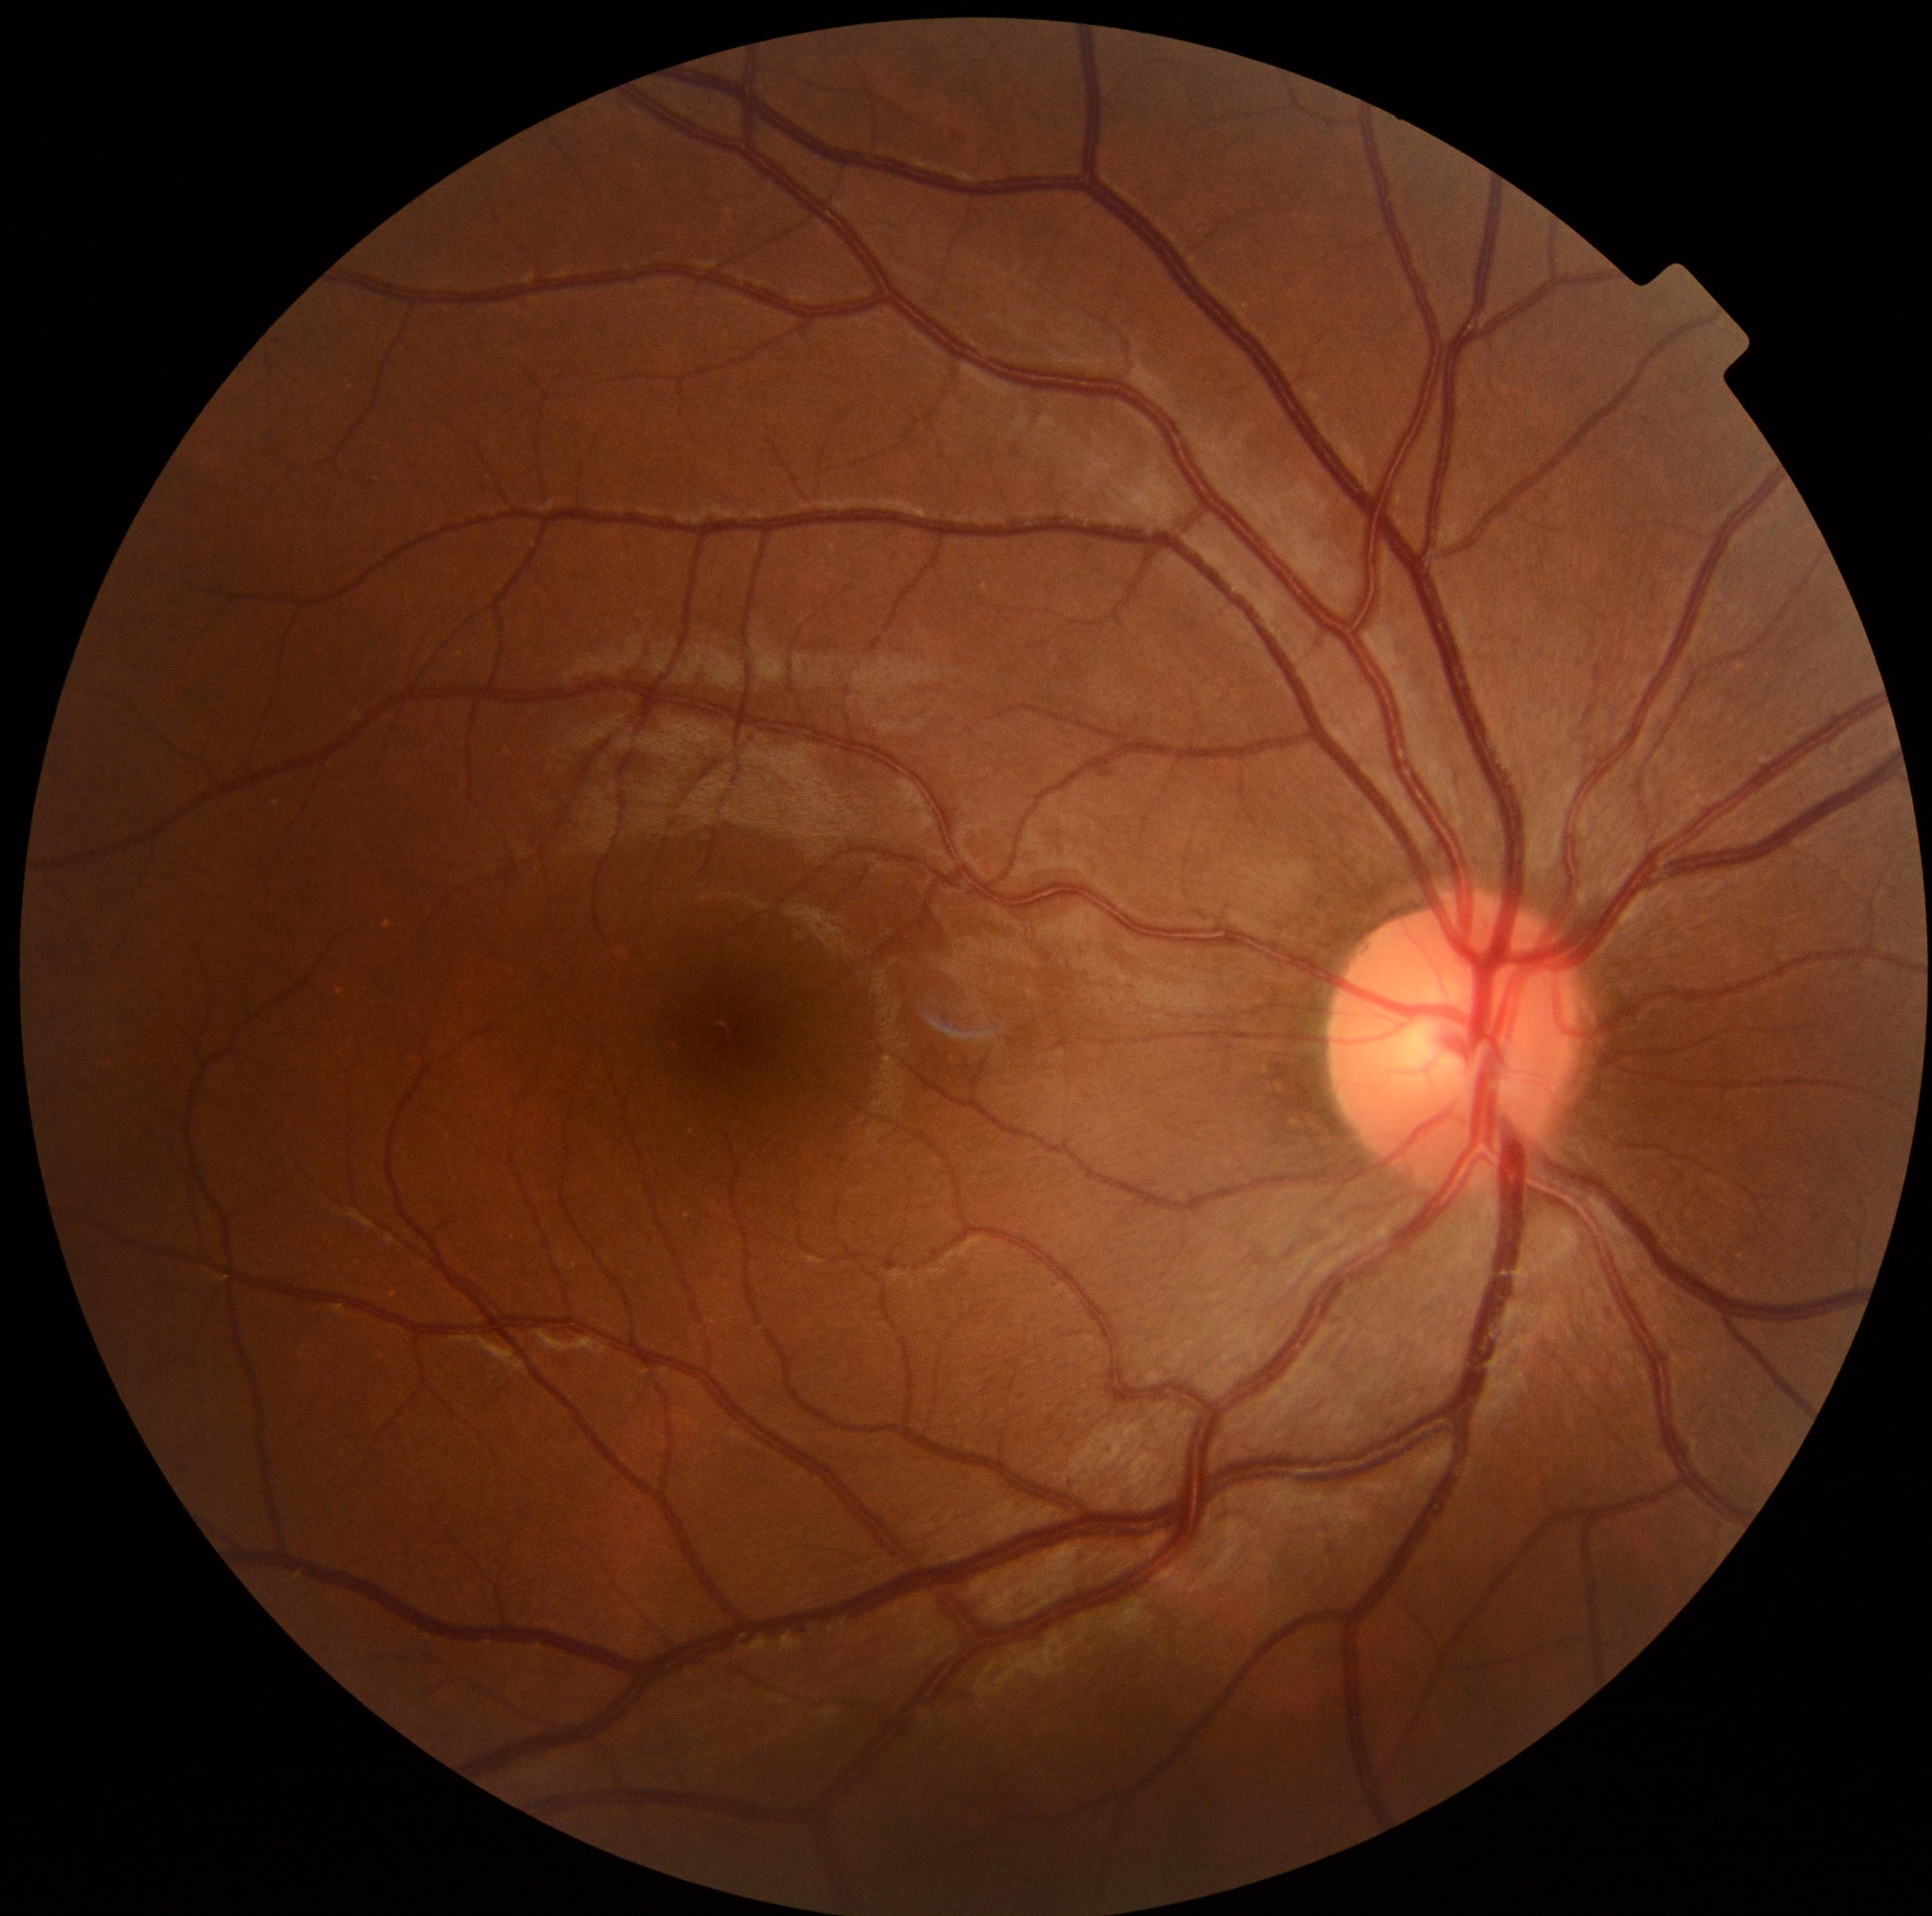

Diabetic retinopathy is no apparent diabetic retinopathy (grade 0).
No signs of diabetic retinopathy.